45 degree fundus photograph; Davis DR grading; 848 by 848 pixels; color fundus image: 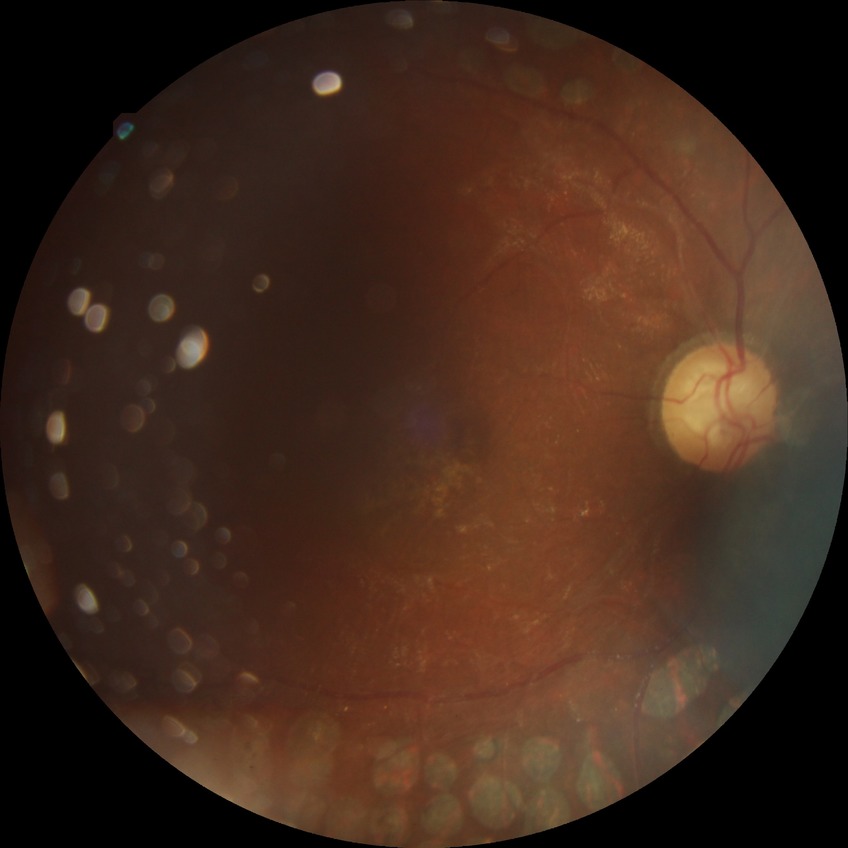 DR grade is PDR.